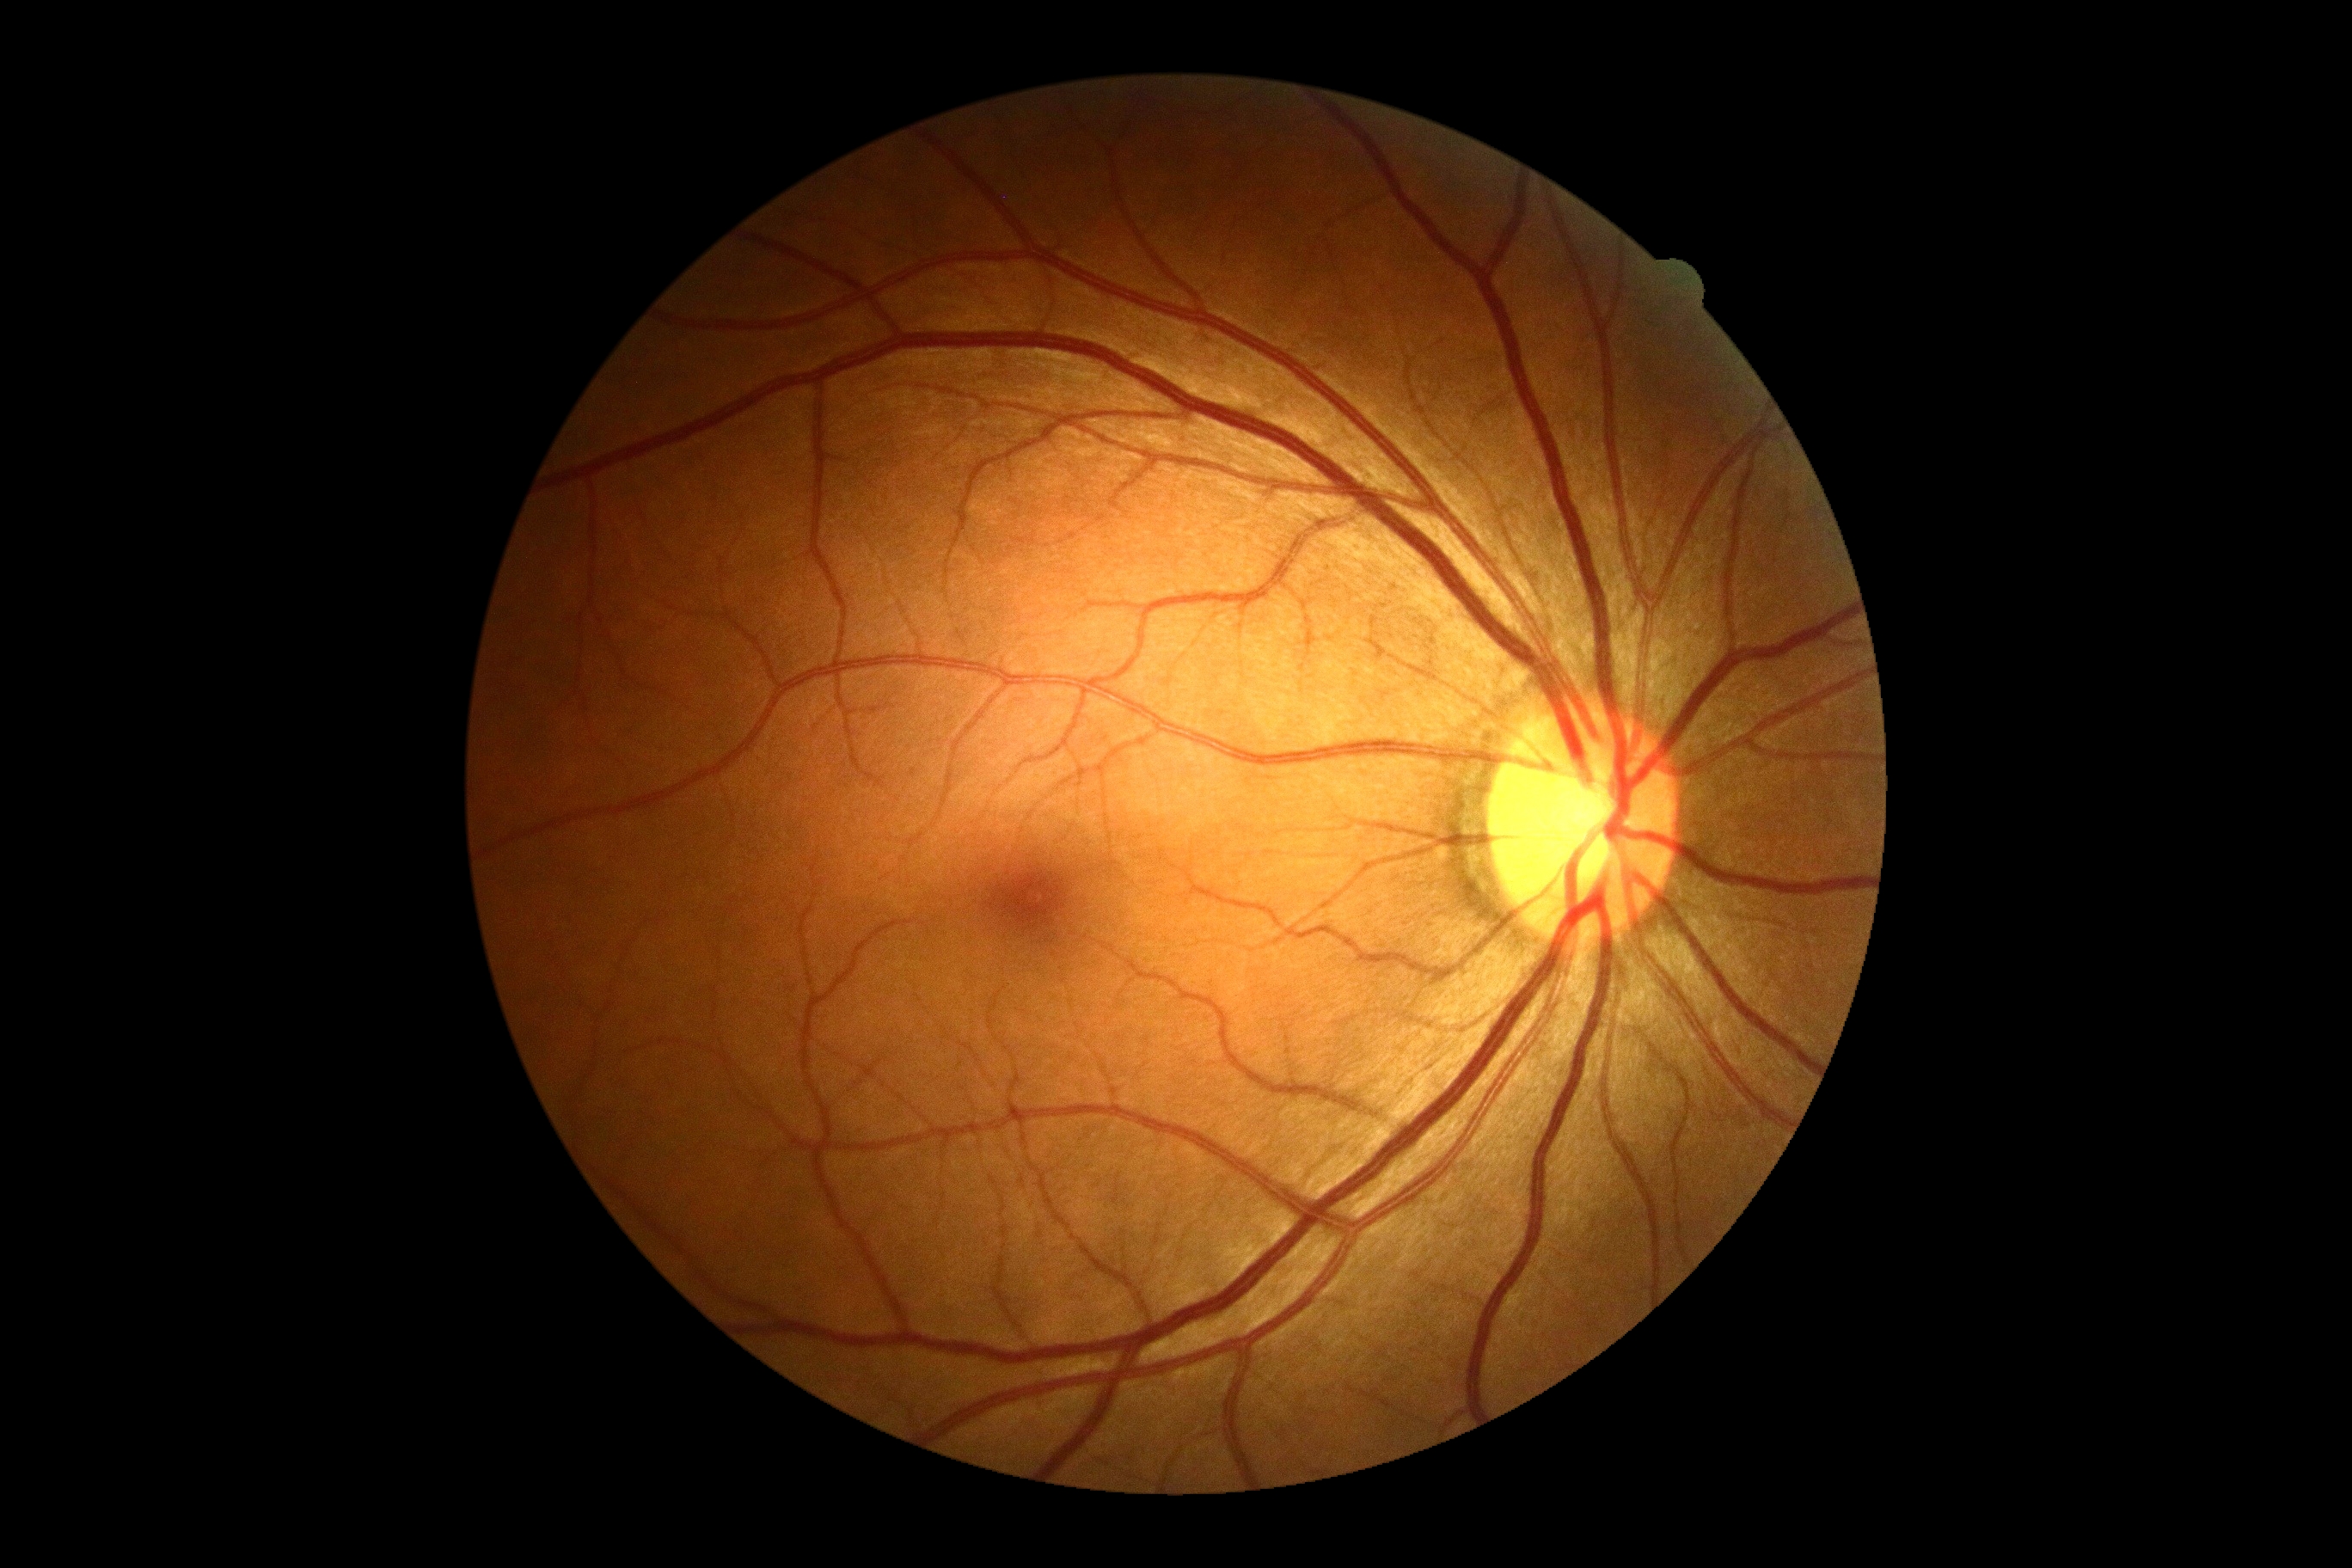
DR: 0.